45° FOV. 1960 x 1897 pixels.
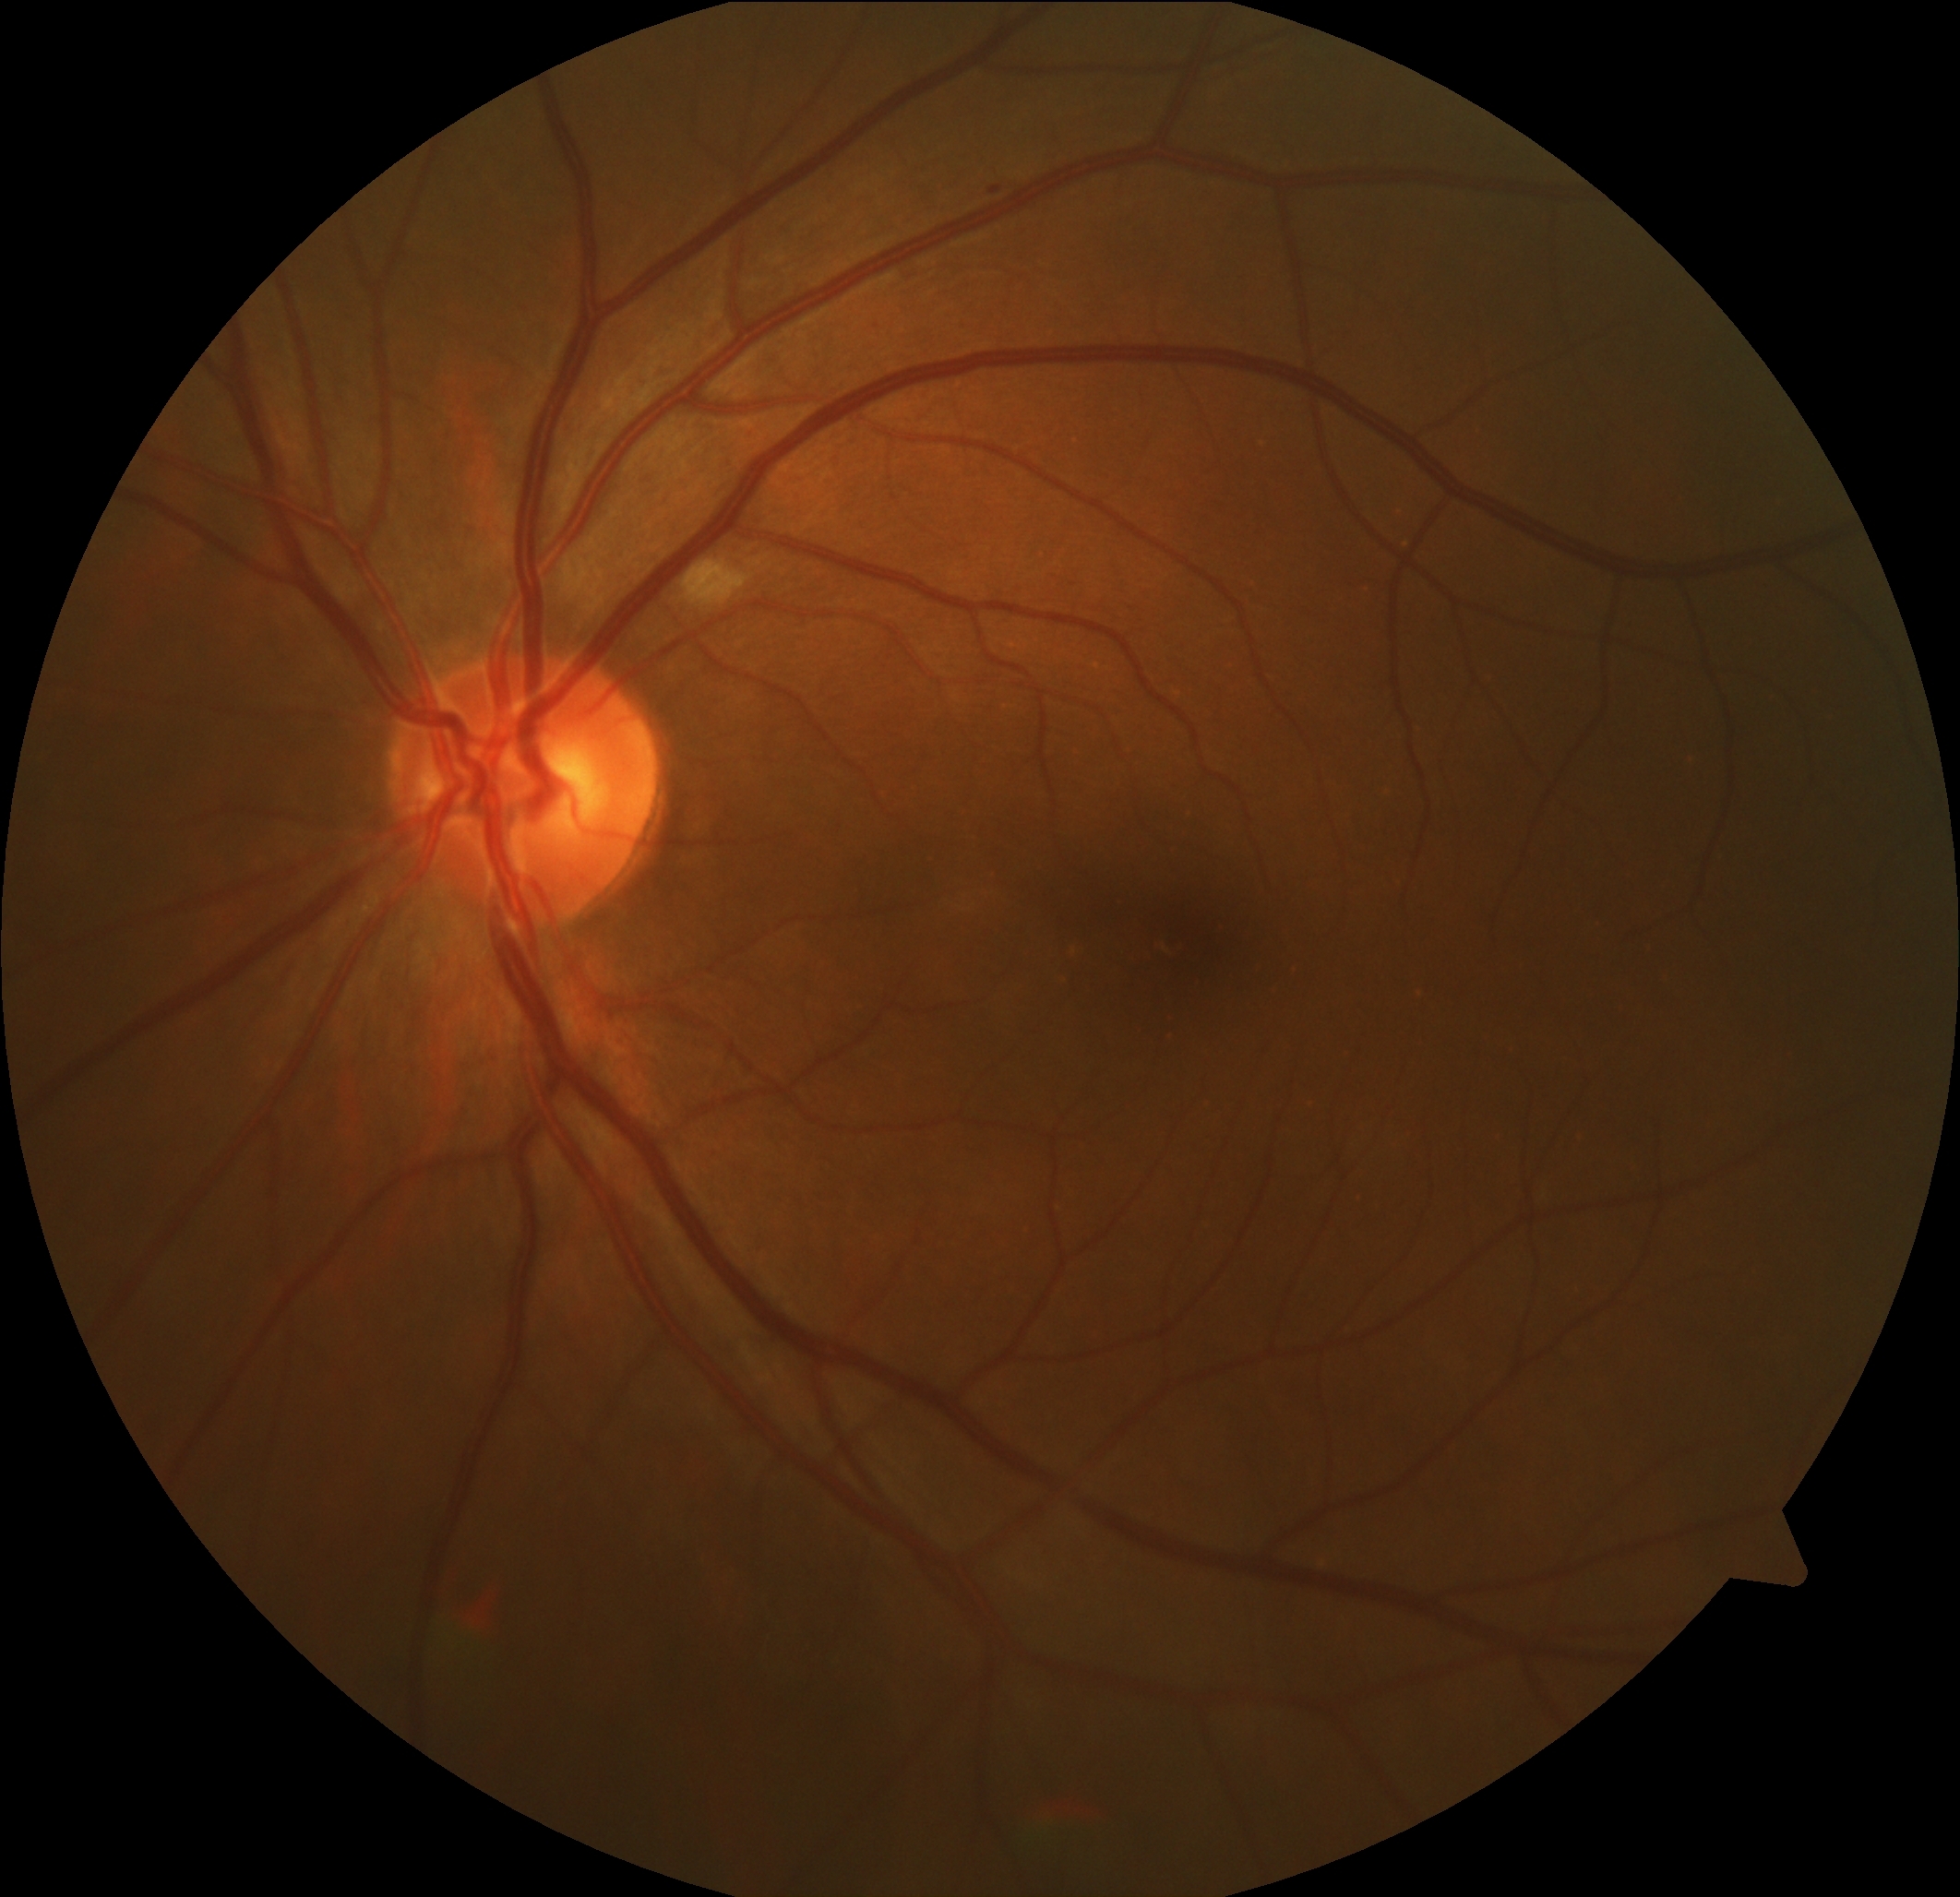 Diabetic retinopathy is 2/4.